Pediatric wide-field fundus photograph. 640 by 480 pixels:
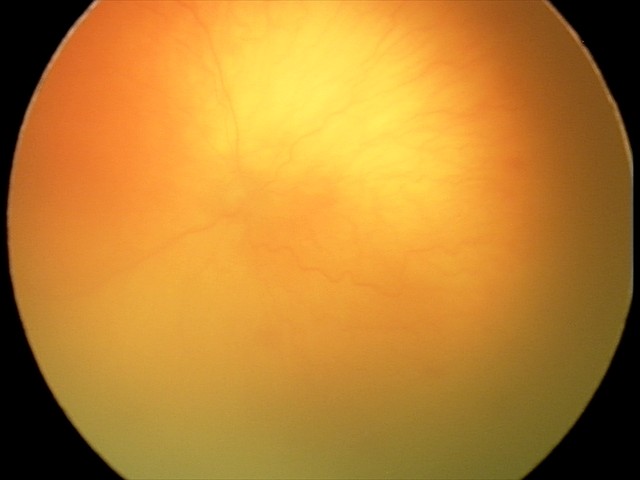

Impression: plus disease — abnormal dilation and tortuosity of the posterior pole retinal vessels; aggressive ROP (A-ROP).